Disc-centered field. Acquired with a Nidek AFC-330.
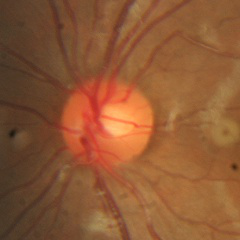

Q: Is glaucoma present?
A: No glaucoma.